Camera: Kowa VX-10α:
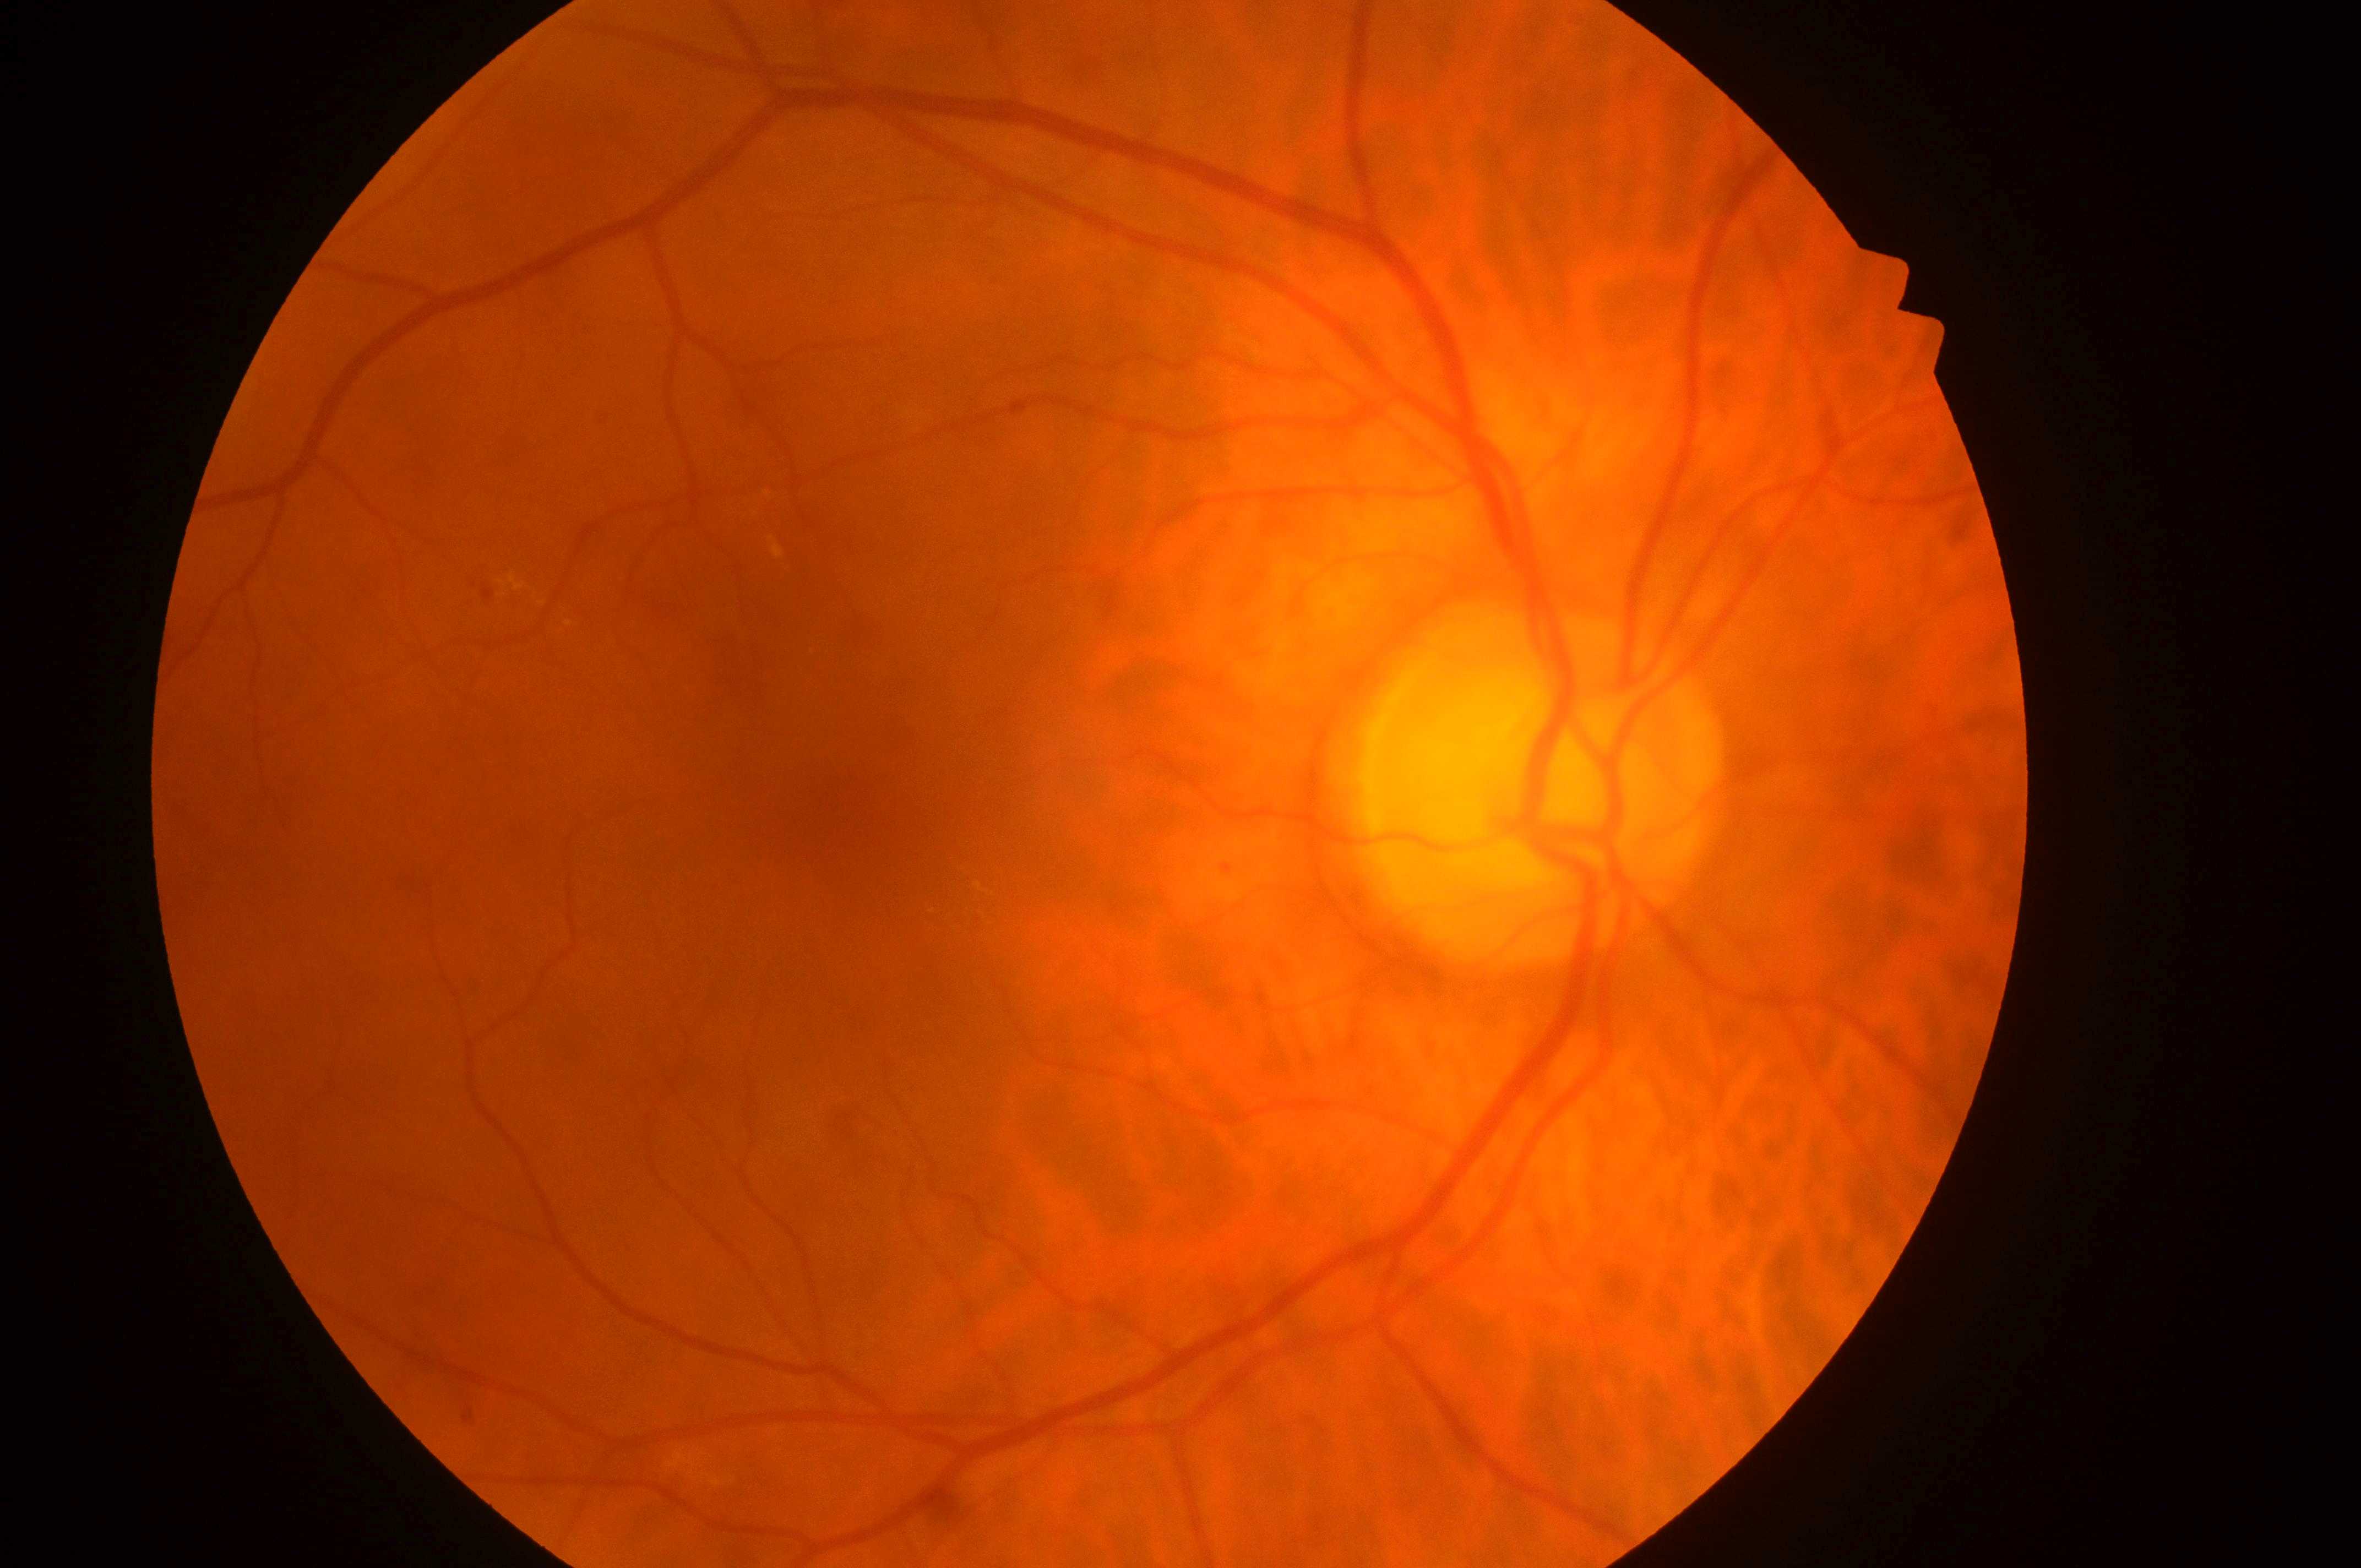 {
  "fovea": "844, 802",
  "dr_grade": "2",
  "eye": "OD",
  "optic_disc": "1531, 800",
  "dme_grade": "2/2"
}